848 by 848 pixels; 45-degree field of view
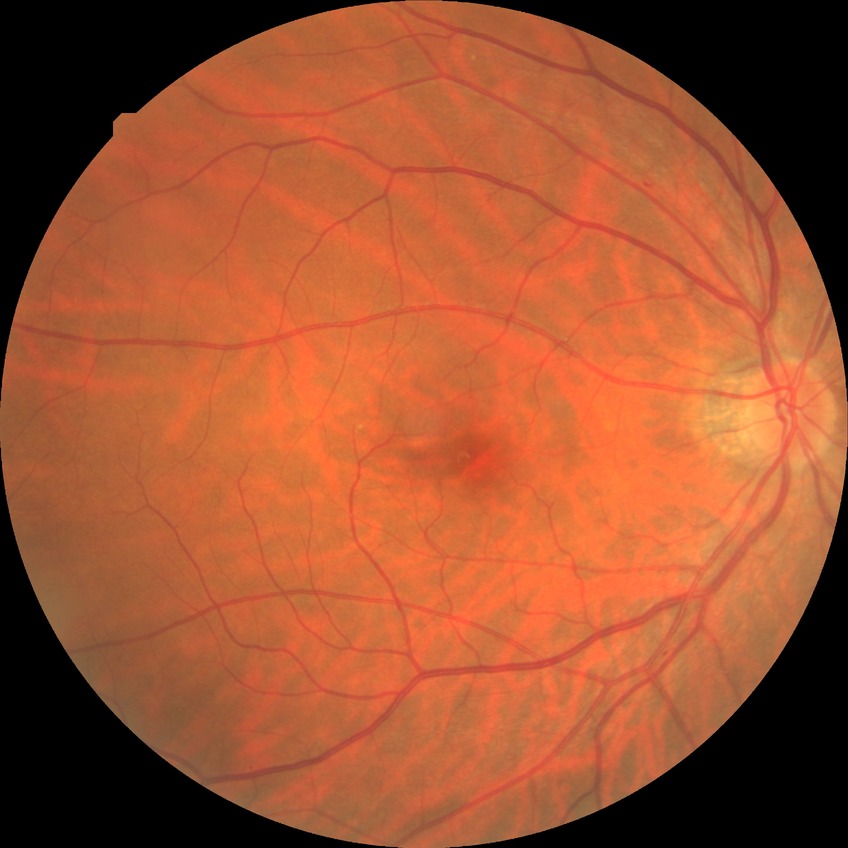 diabetic retinopathy (DR)@SDR (simple diabetic retinopathy).